Modified Davis classification: 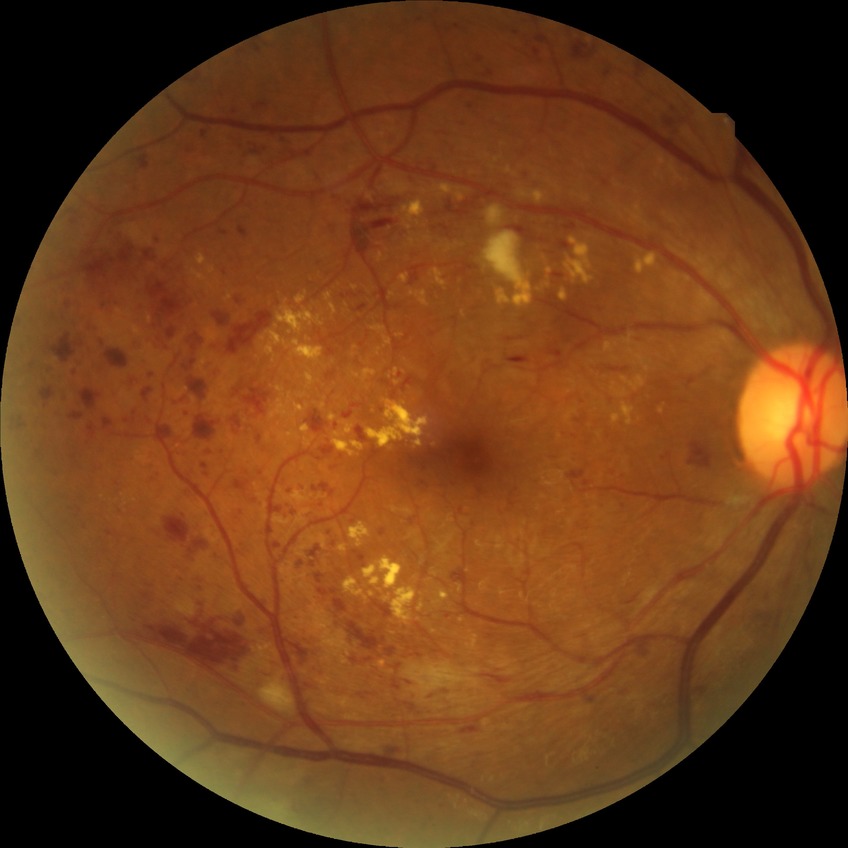

Diabetic retinopathy (DR) is pre-proliferative diabetic retinopathy (PPDR).